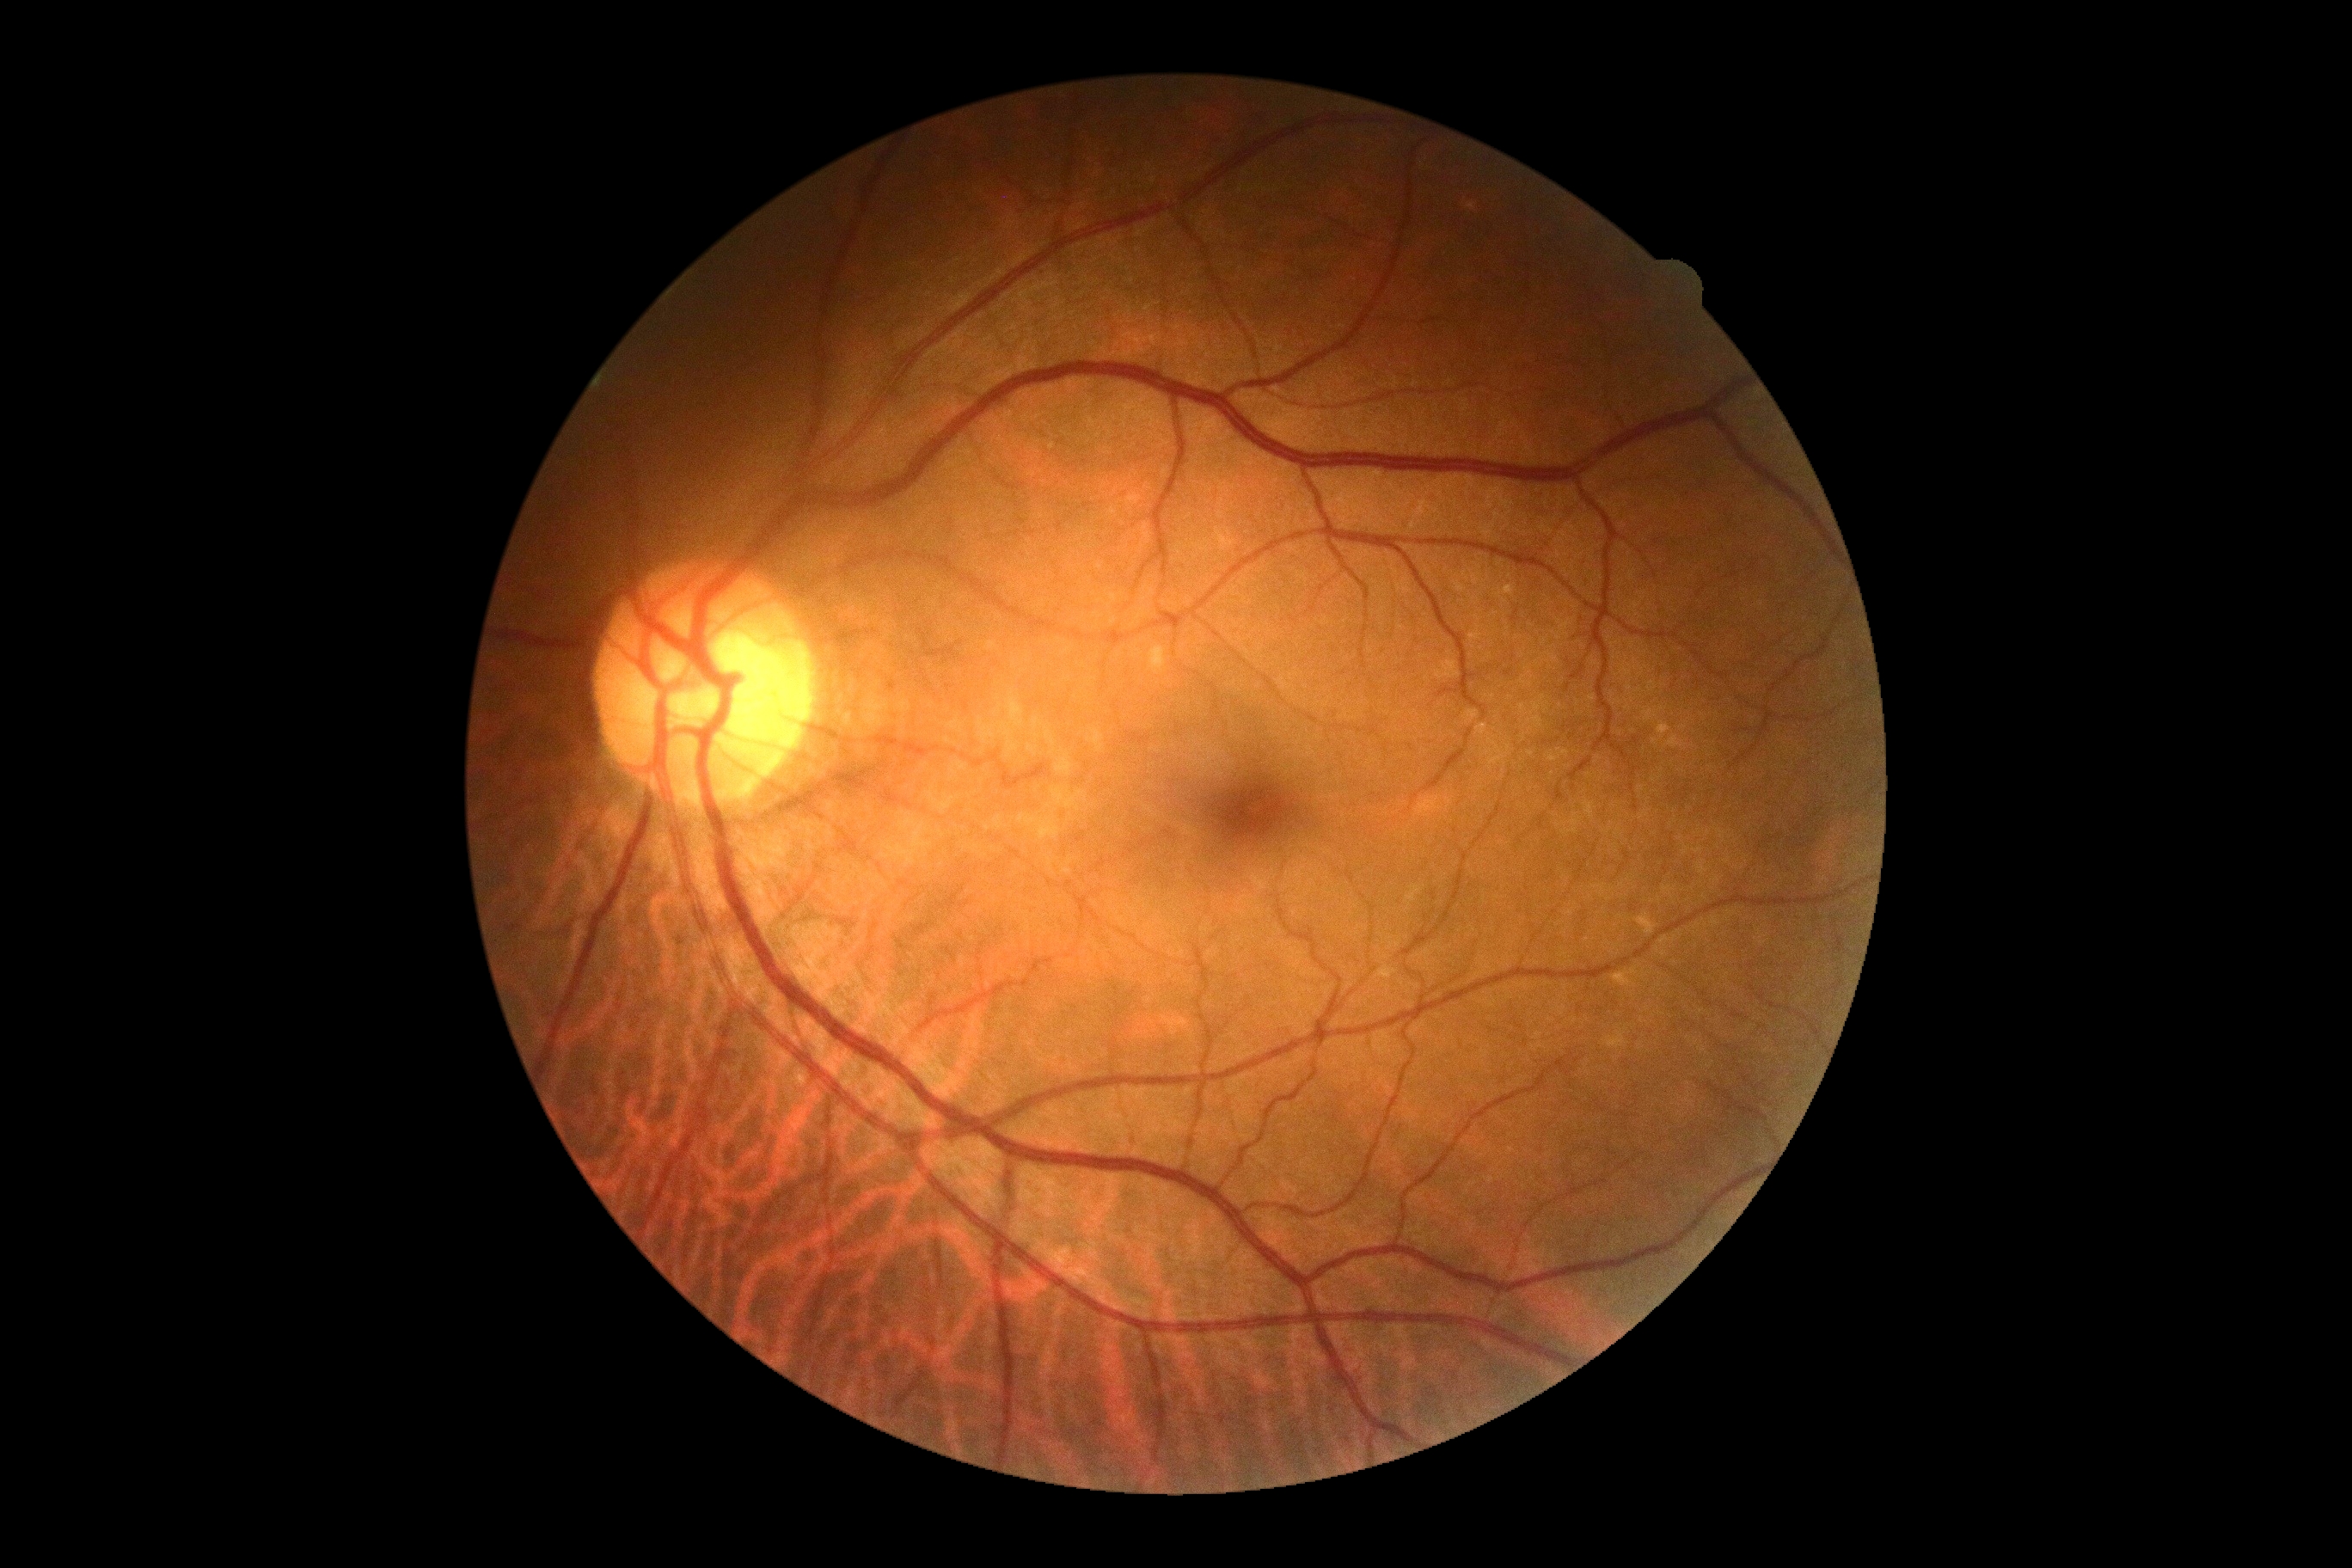
Diabetic retinopathy: grade 0 (no apparent retinopathy).